Camera: NIDEK AFC-230, 848x848px, retinal fundus photograph — 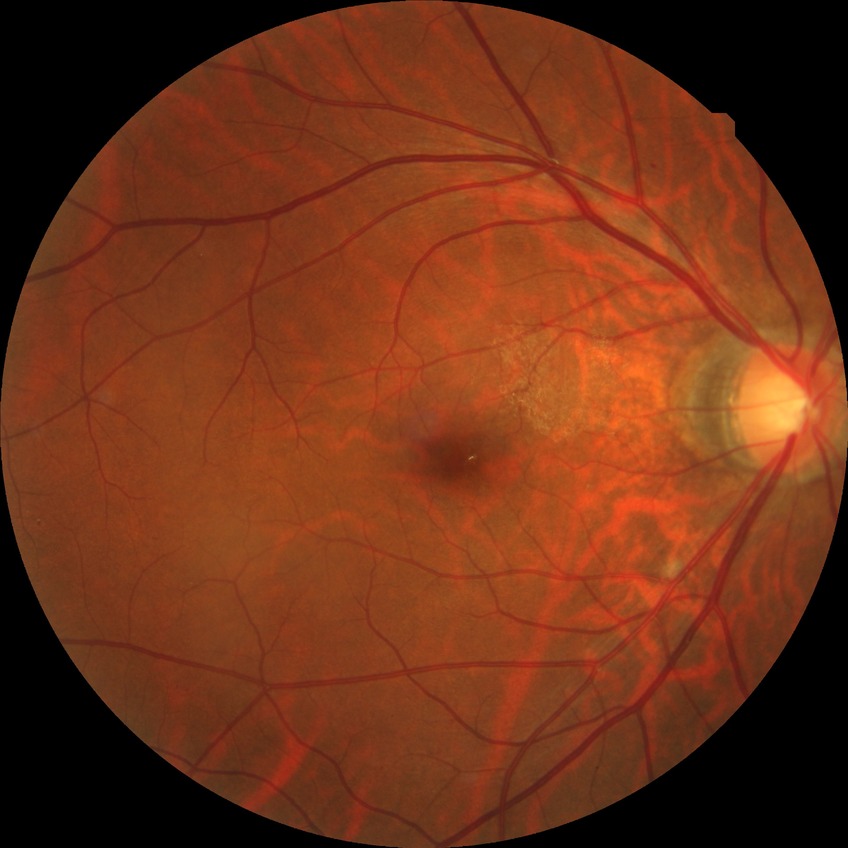 Davis grading: simple diabetic retinopathy.